1932x1932px. 45° FOV:
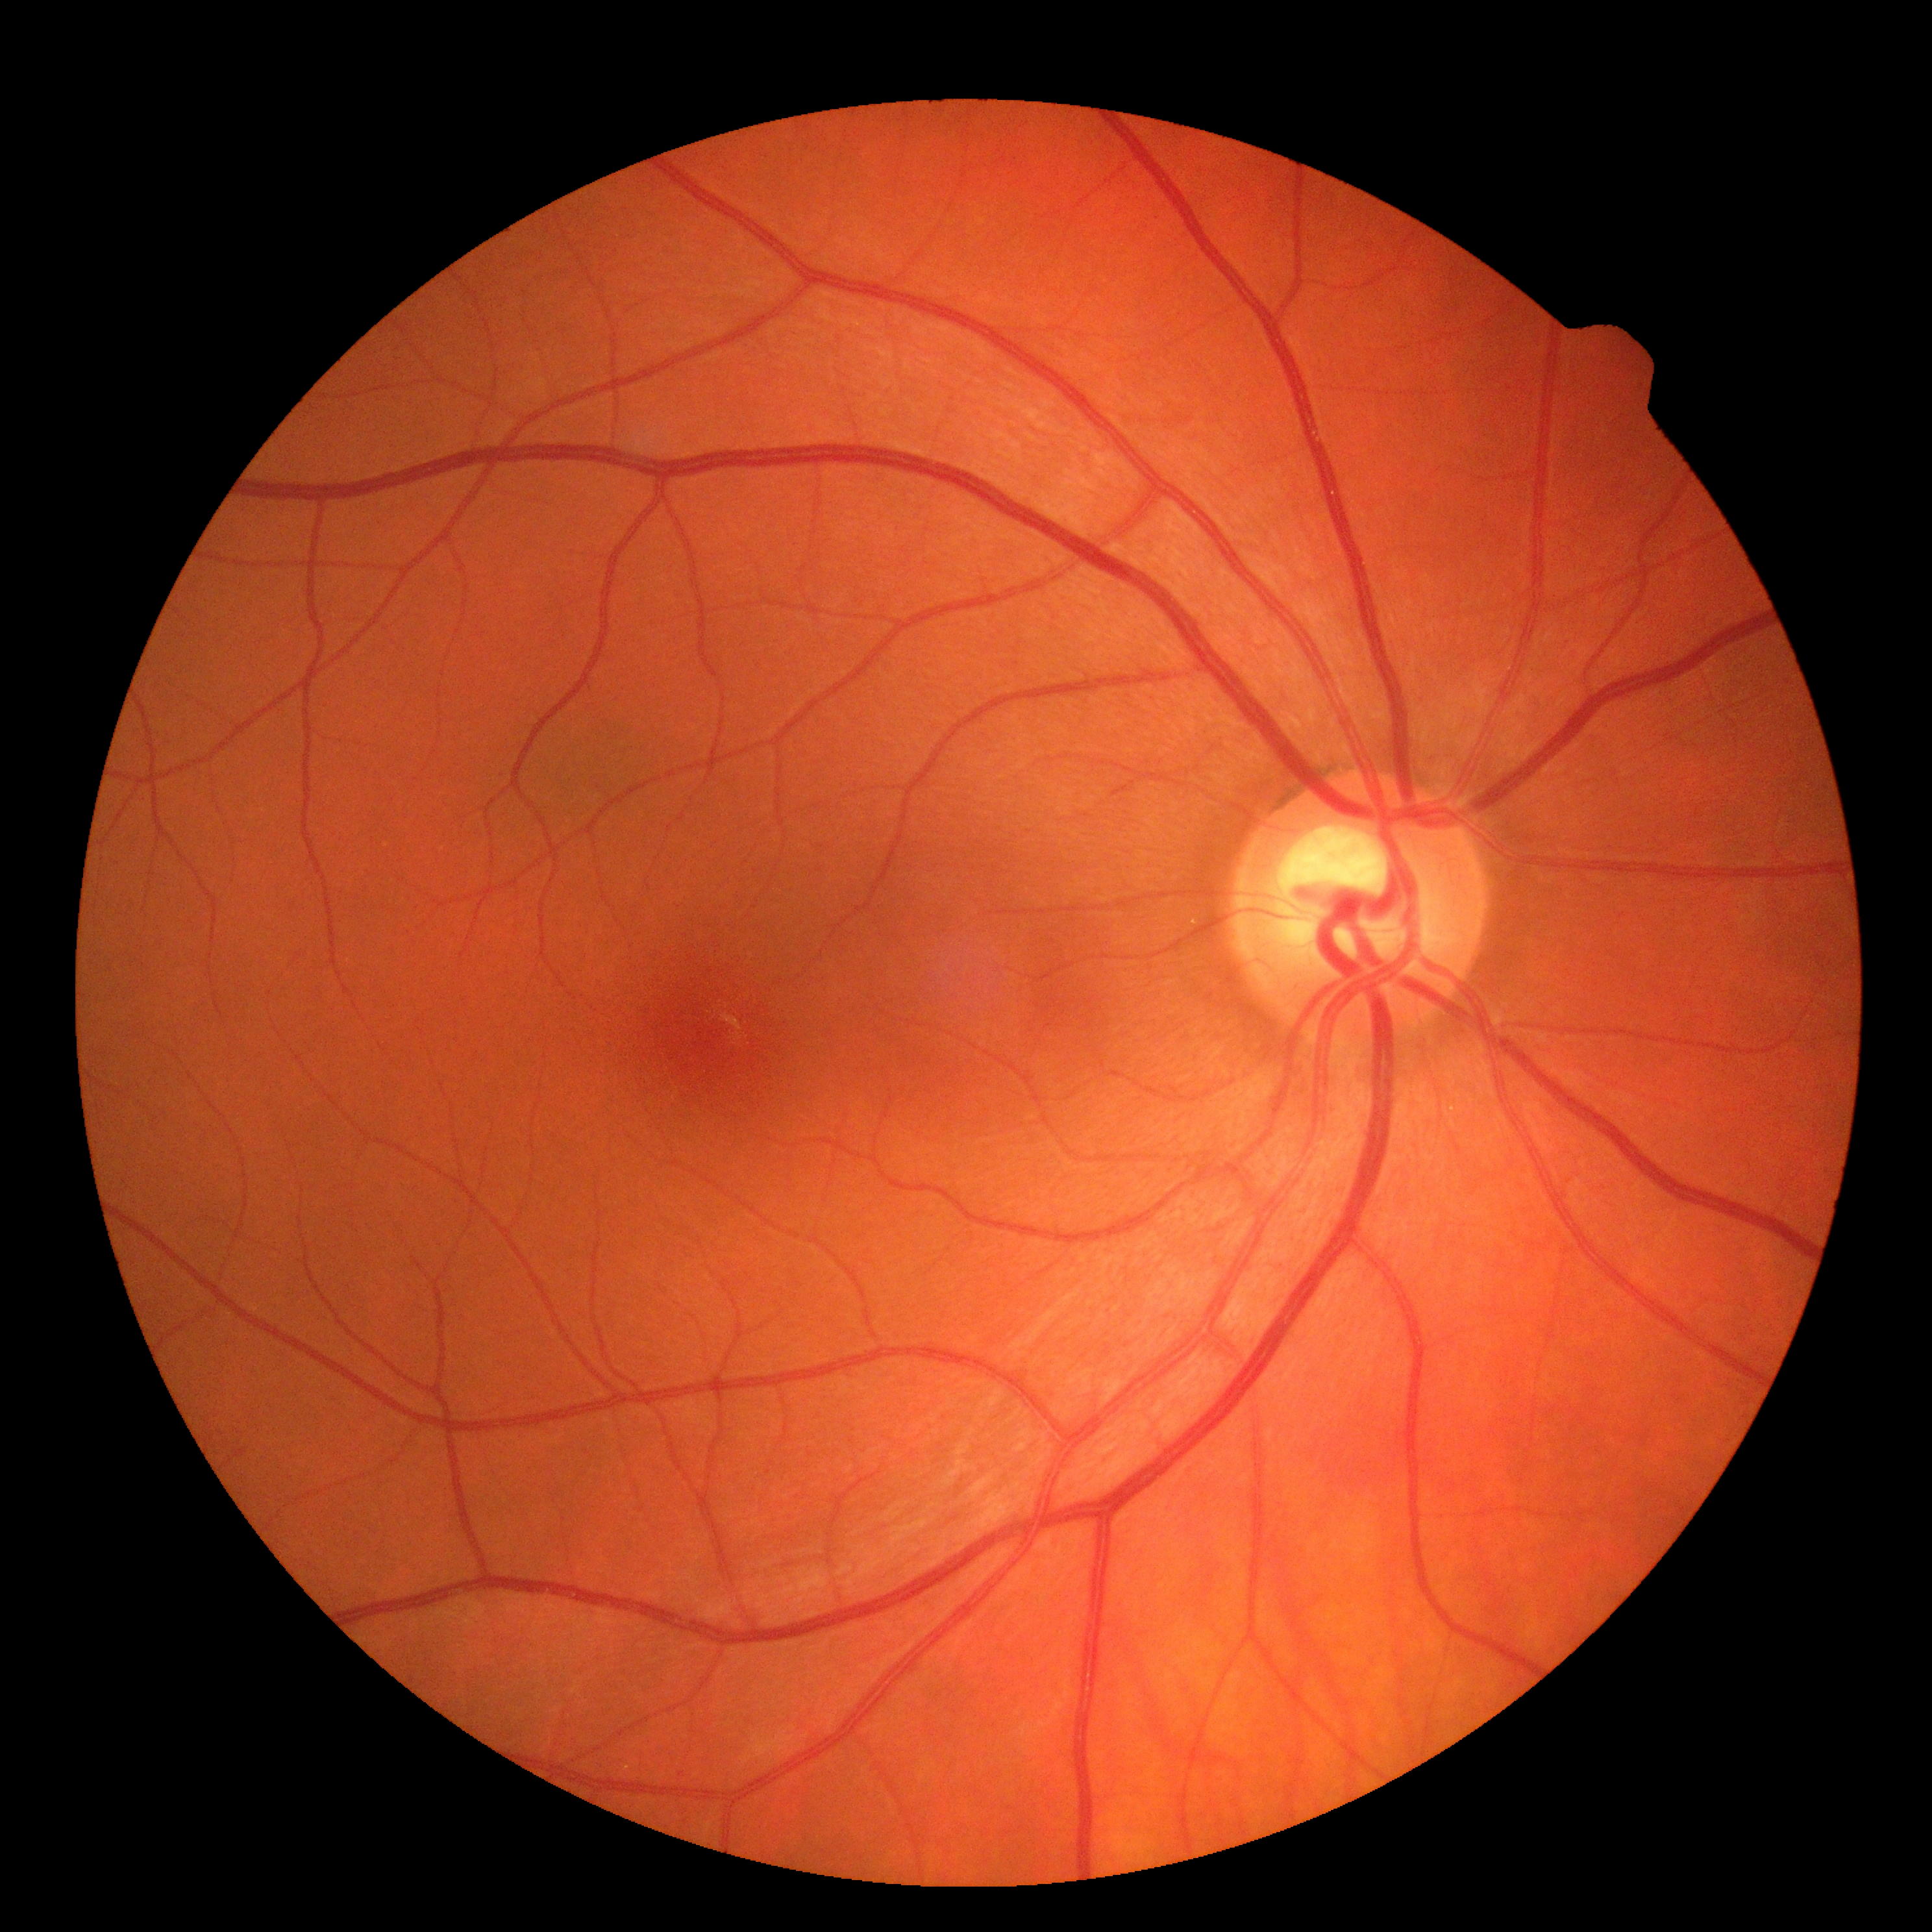 Annotations:
* DR impression: no DR findings
* diabetic retinopathy (DR): 0